Camera: Phoenix ICON (100° FOV); wide-field fundus image from infant ROP screening — 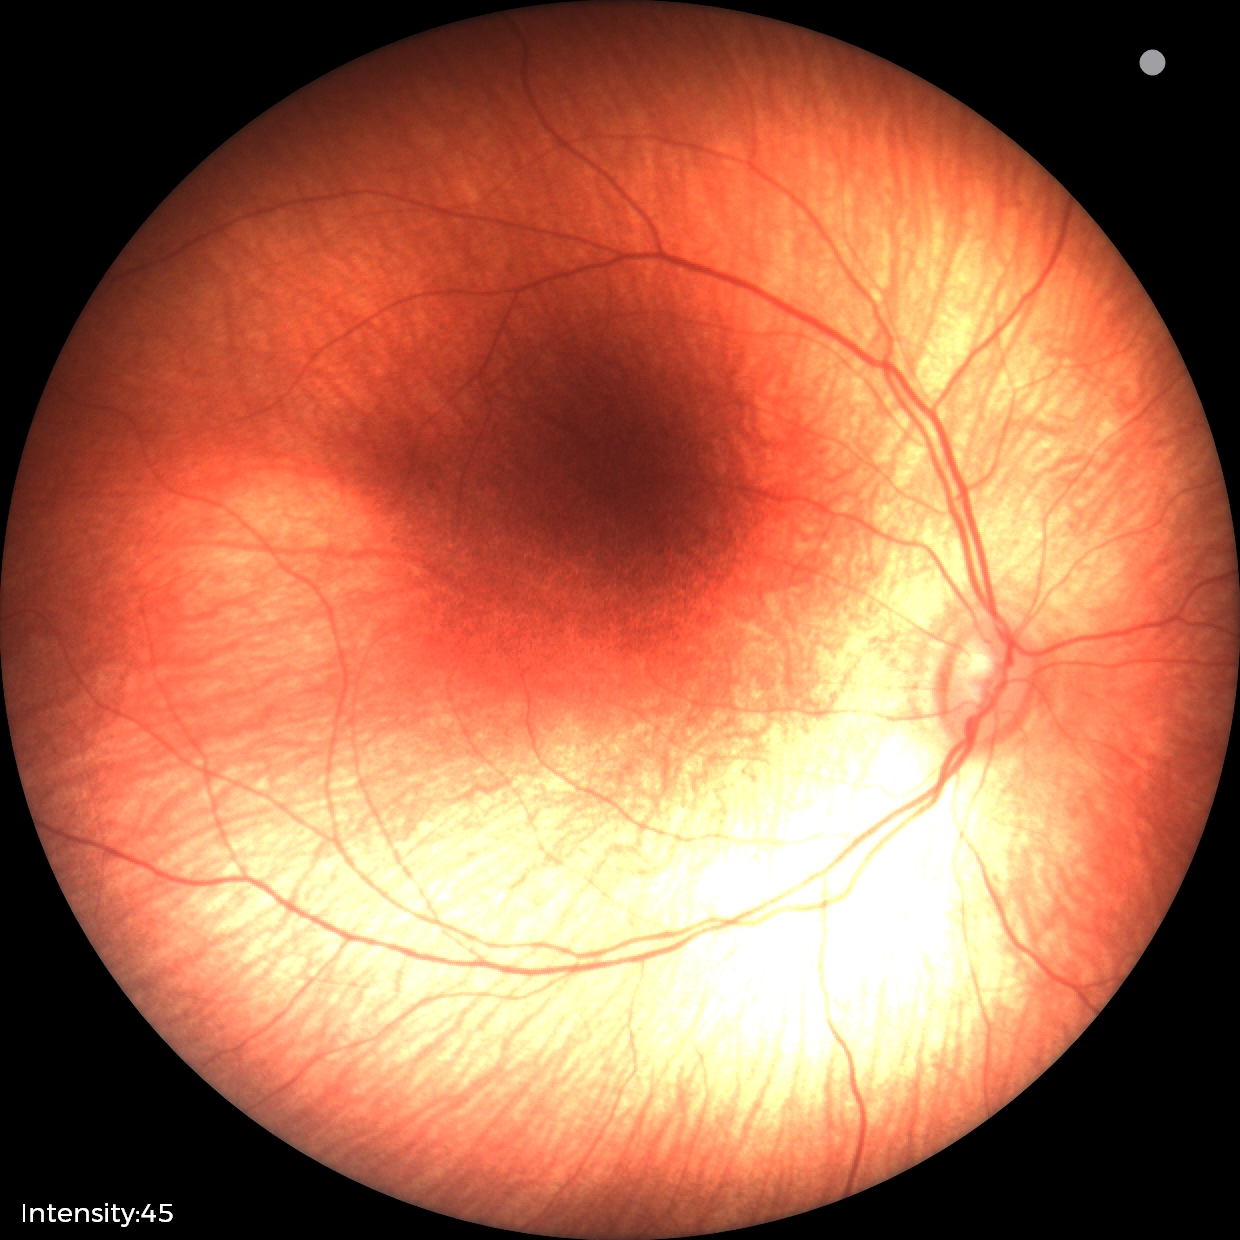
Impression = status post ROP